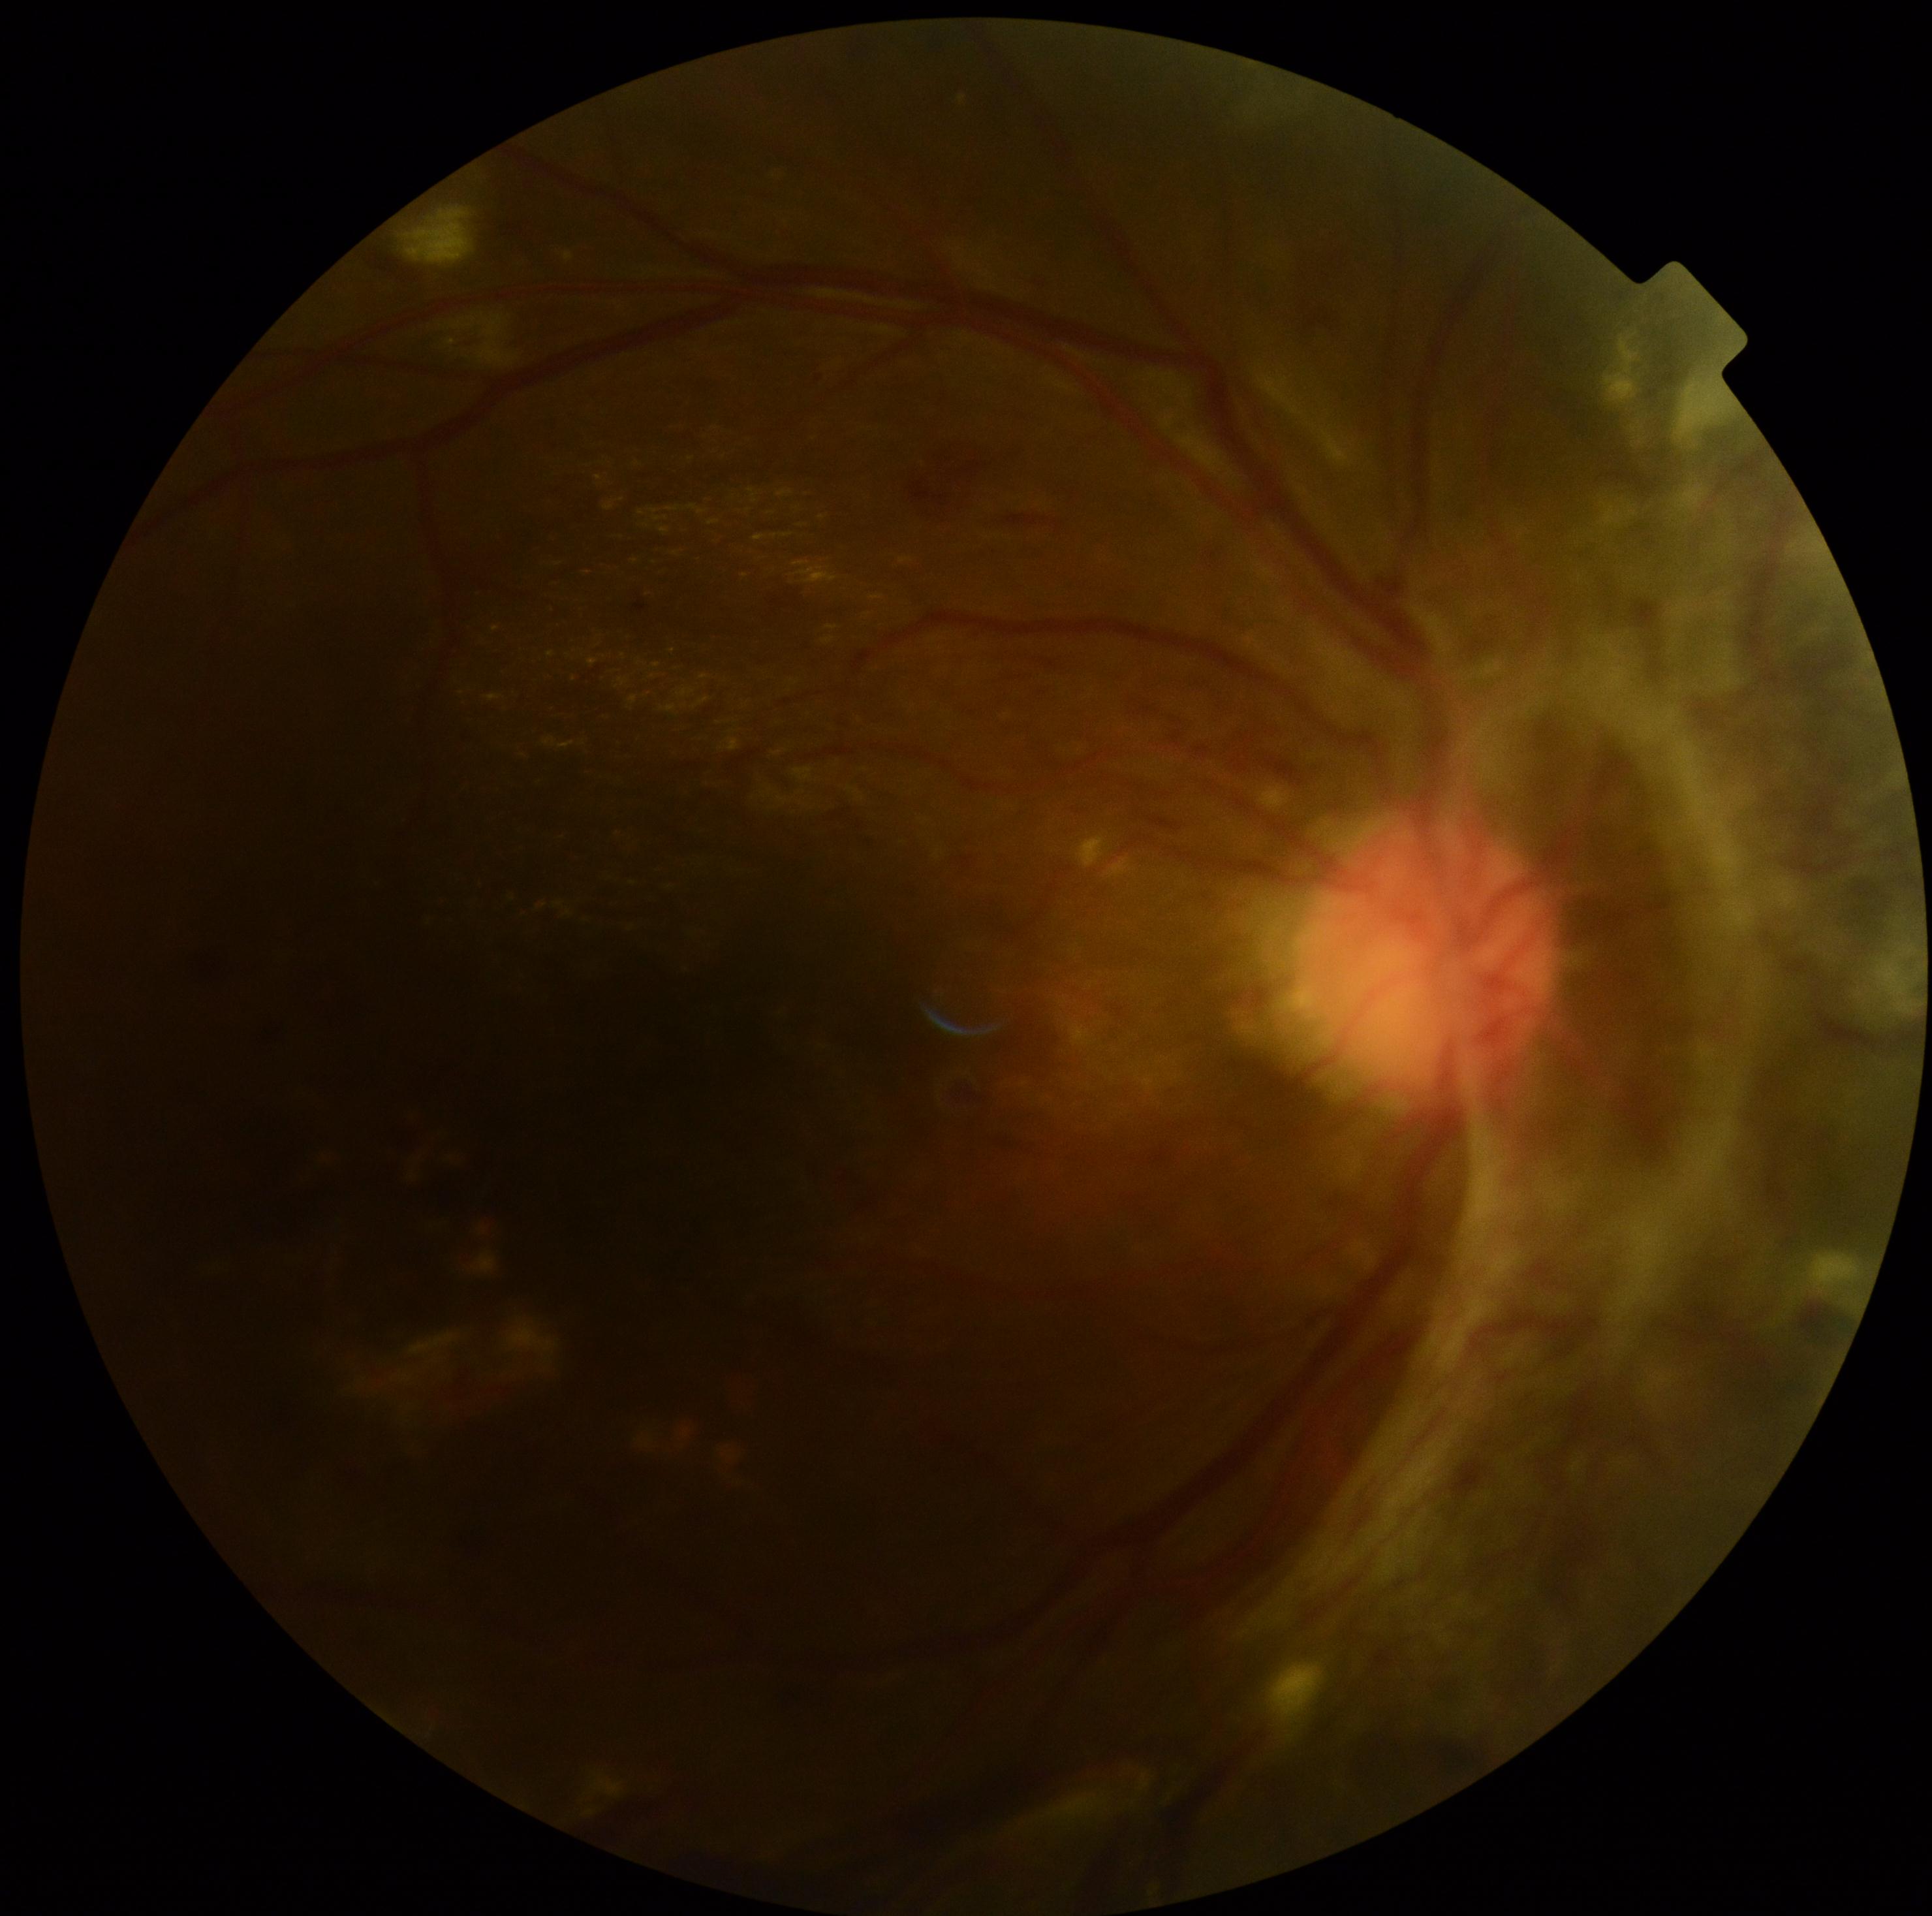 DR stage: grade 4.
DR class: proliferative diabetic retinopathy.